Color fundus image · 848 x 848 pixels · no pharmacologic dilation: 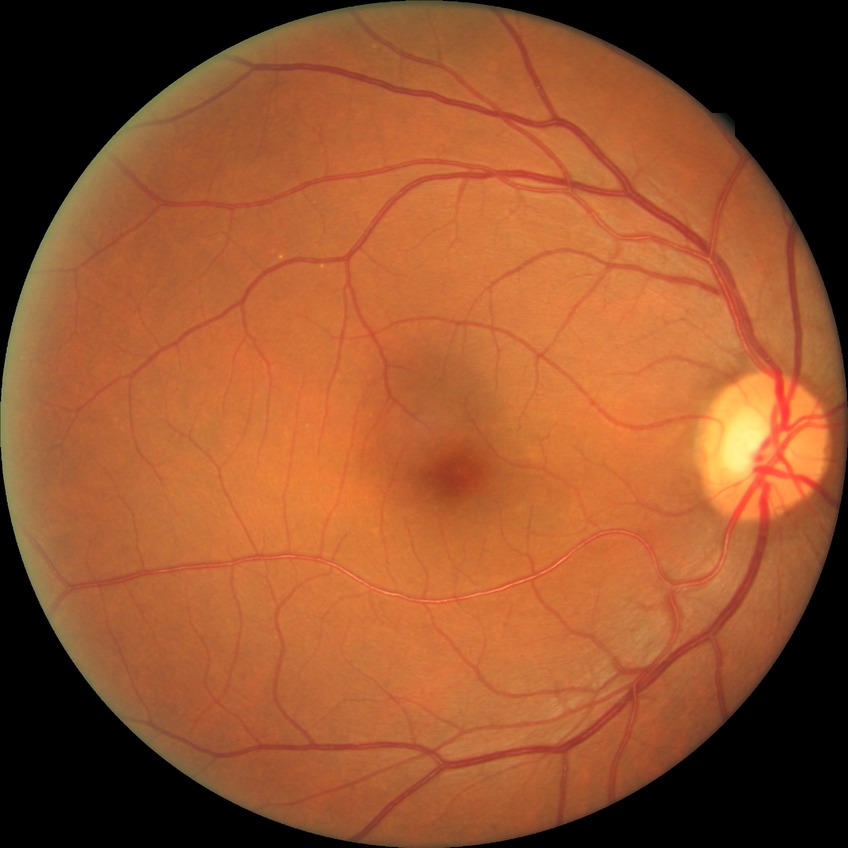
Diabetic retinopathy stage: no diabetic retinopathy.